Fundus photograph cropped around the optic nerve head · mydriatic: 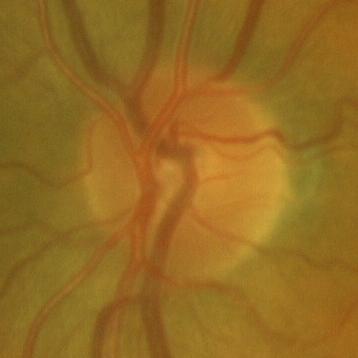 Q: Is glaucoma present?
A: No — no glaucomatous findings.